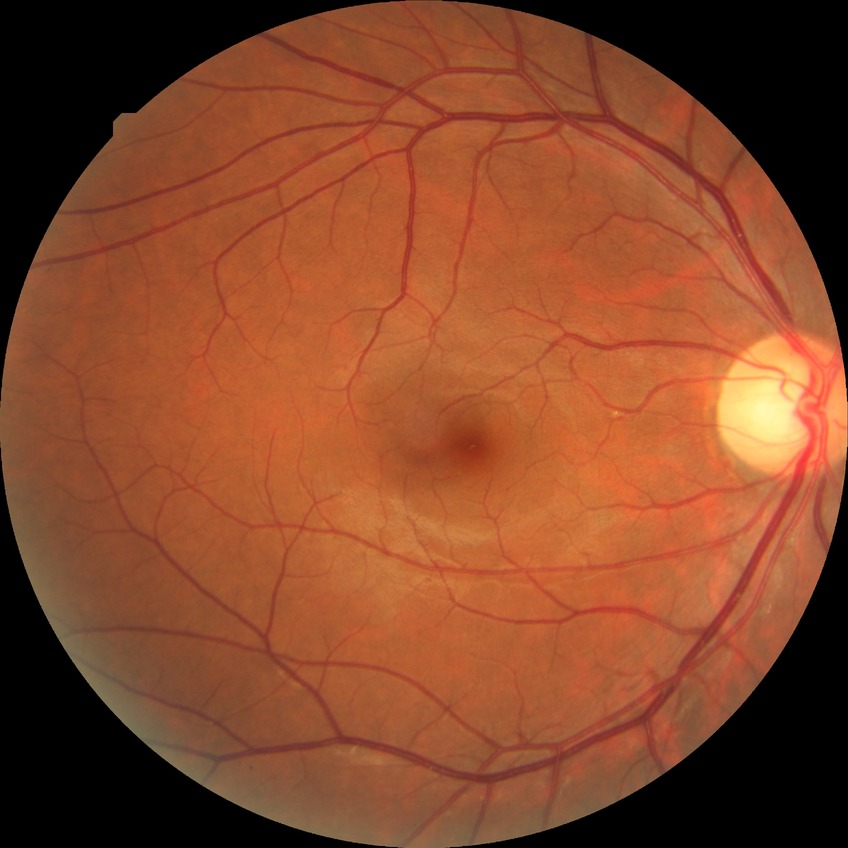 Assessment:
• diabetic retinopathy (DR): NDR (no diabetic retinopathy)